Color fundus image.
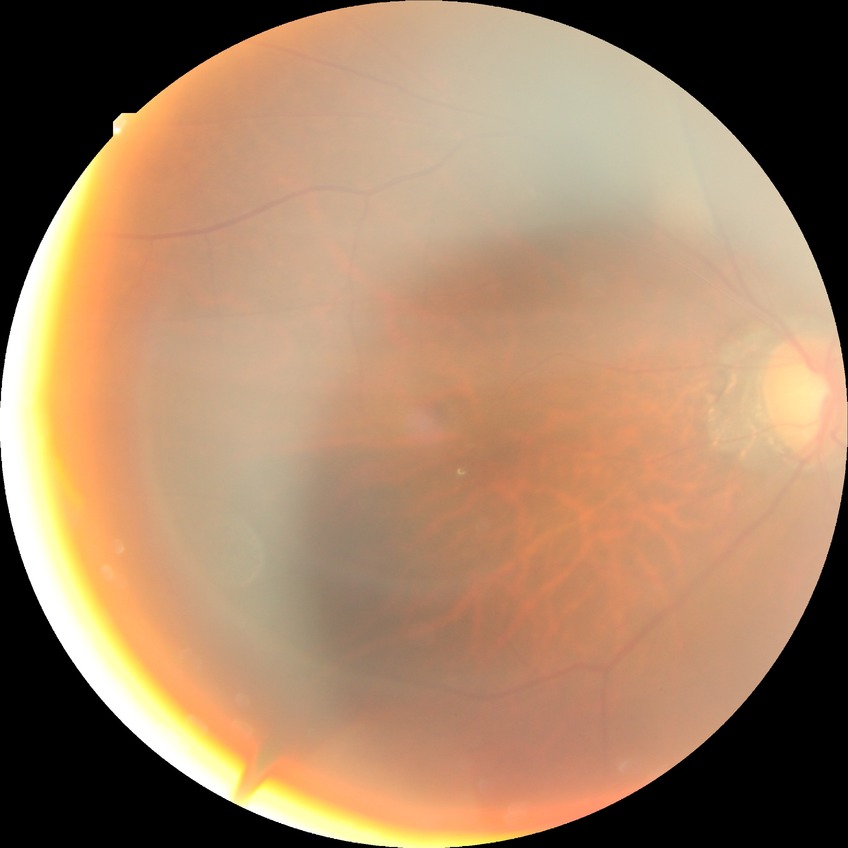 retinopathy stage=no diabetic retinopathy.